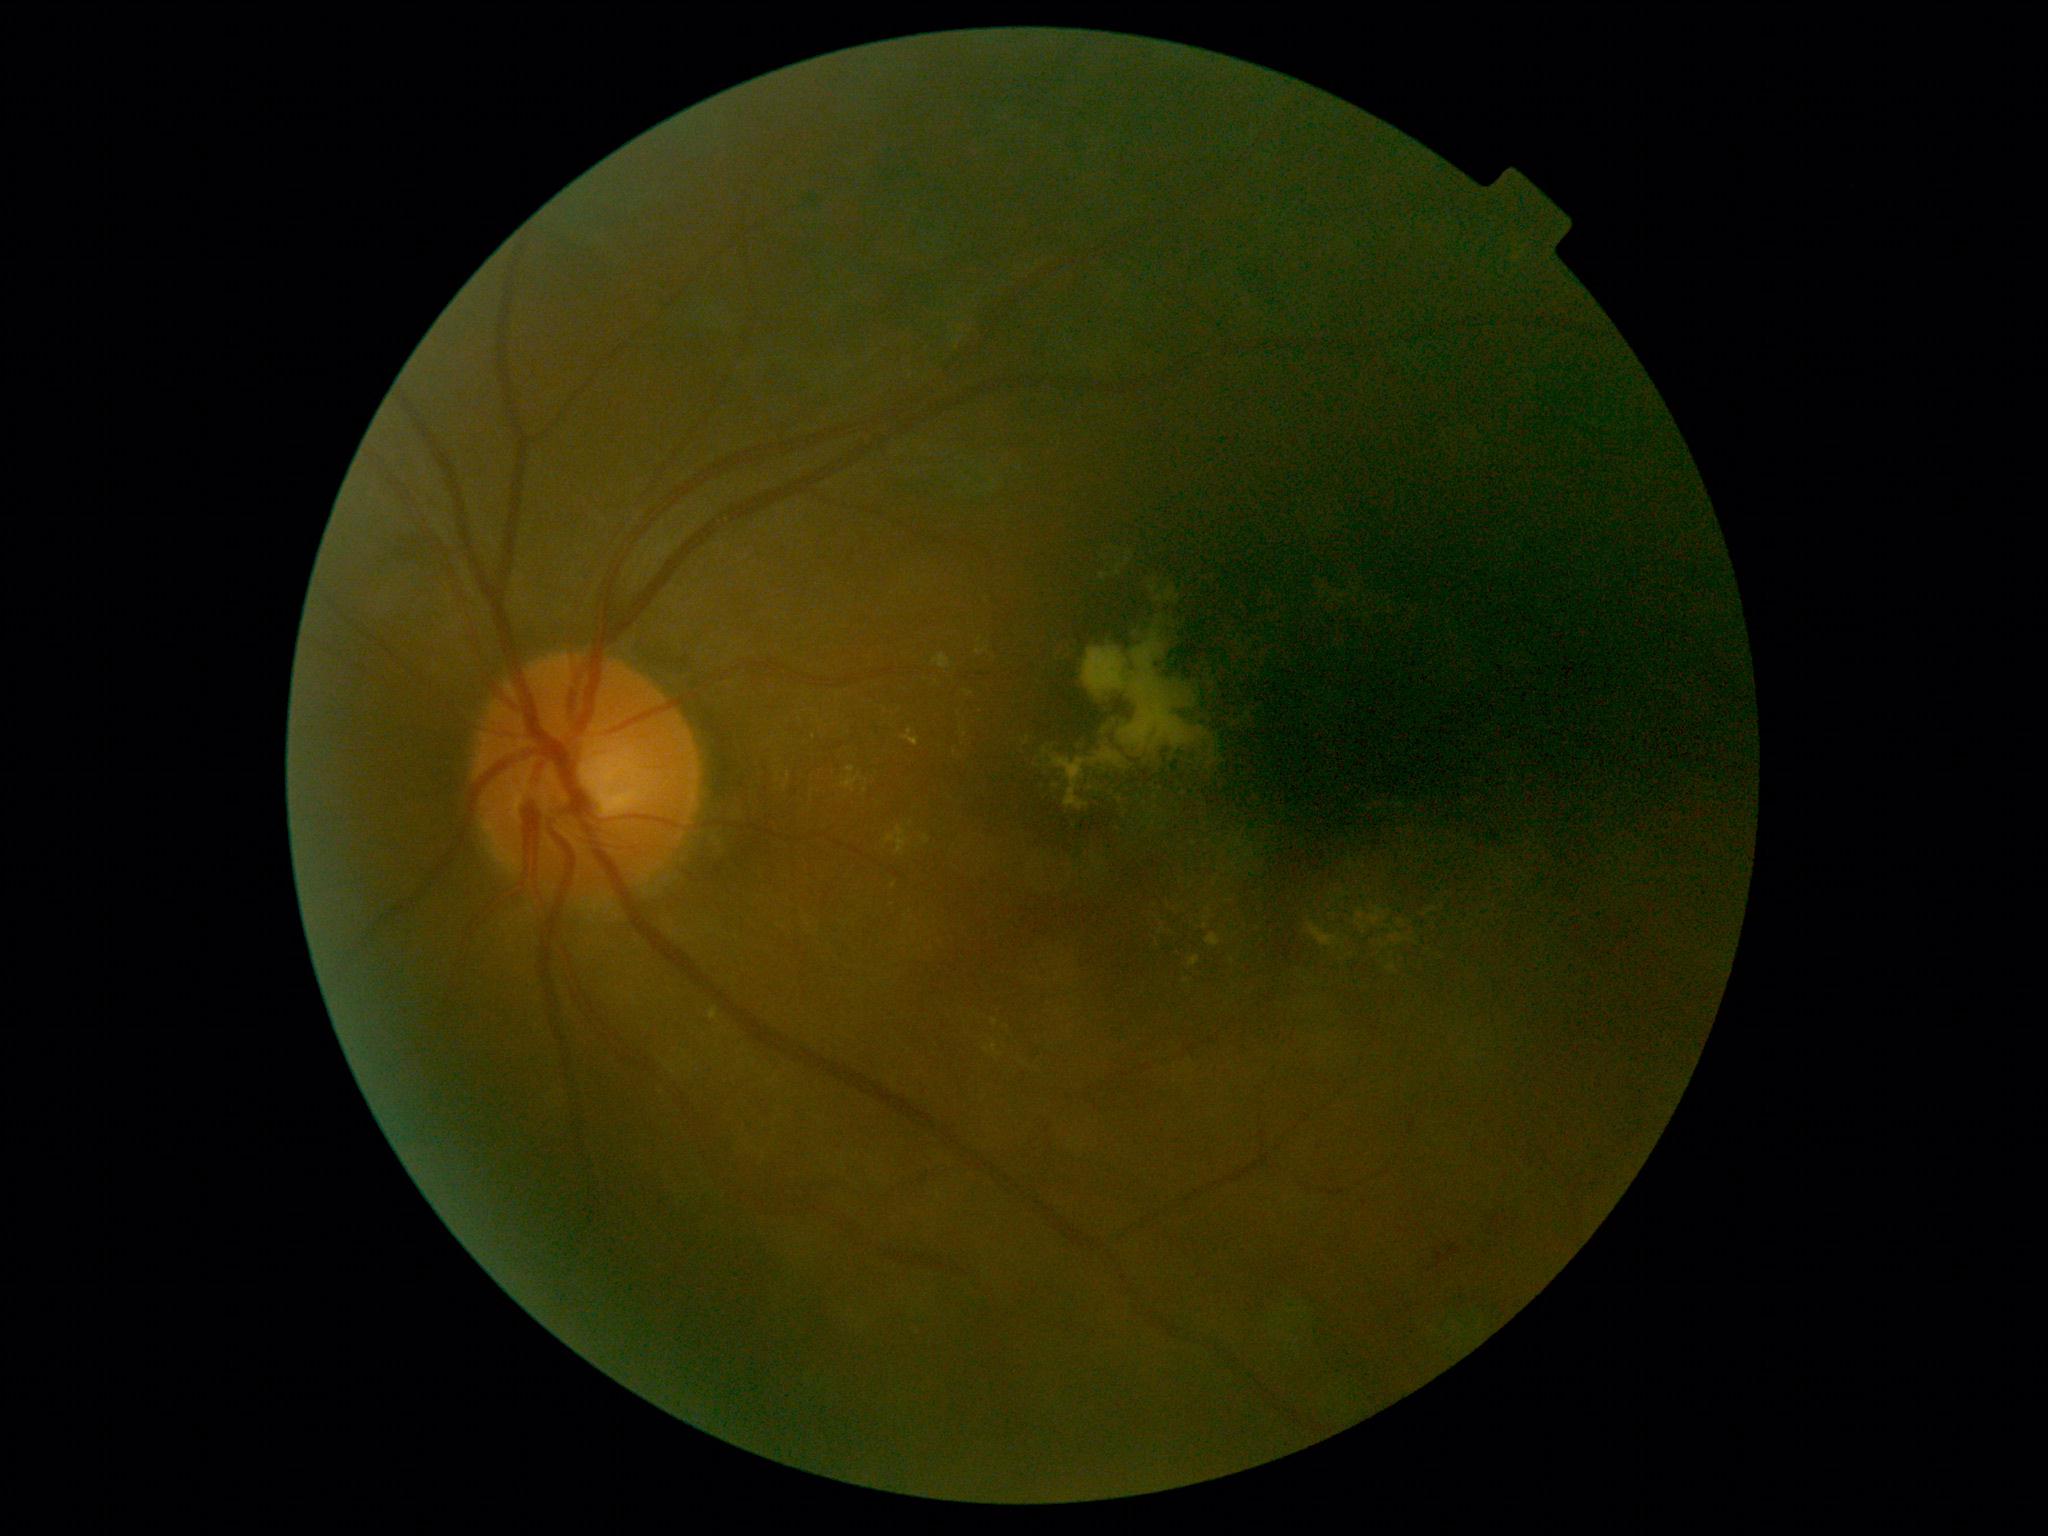
{
  "dr_grade": "grade 2"
}